DR severity per modified Davis staging
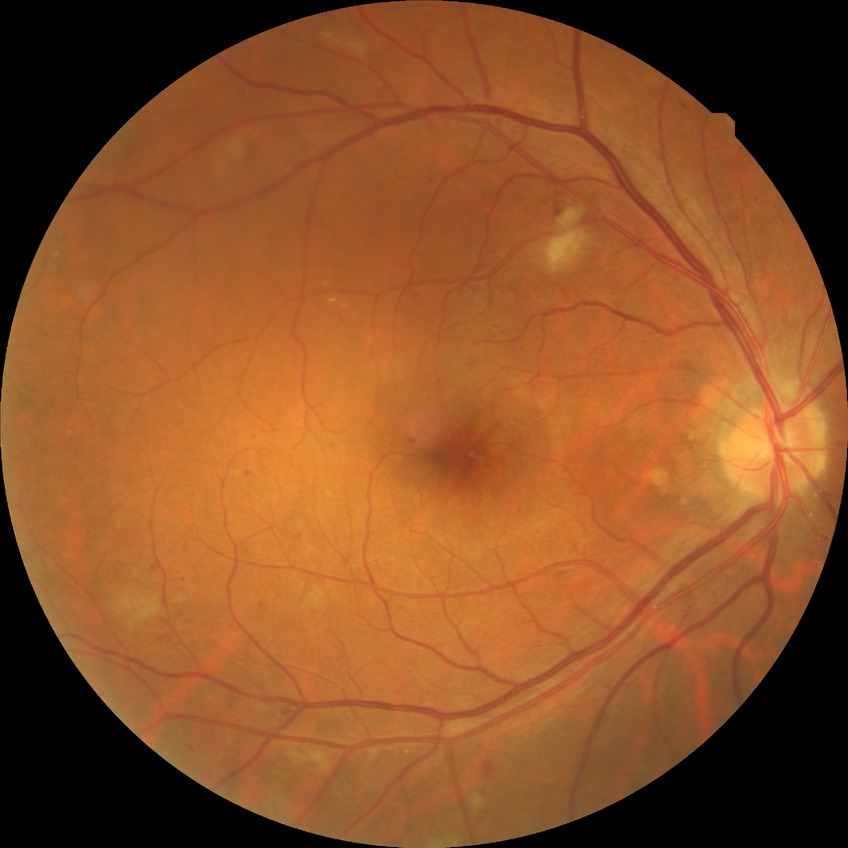 {"davis_grade": "SDR (simple diabetic retinopathy)"}